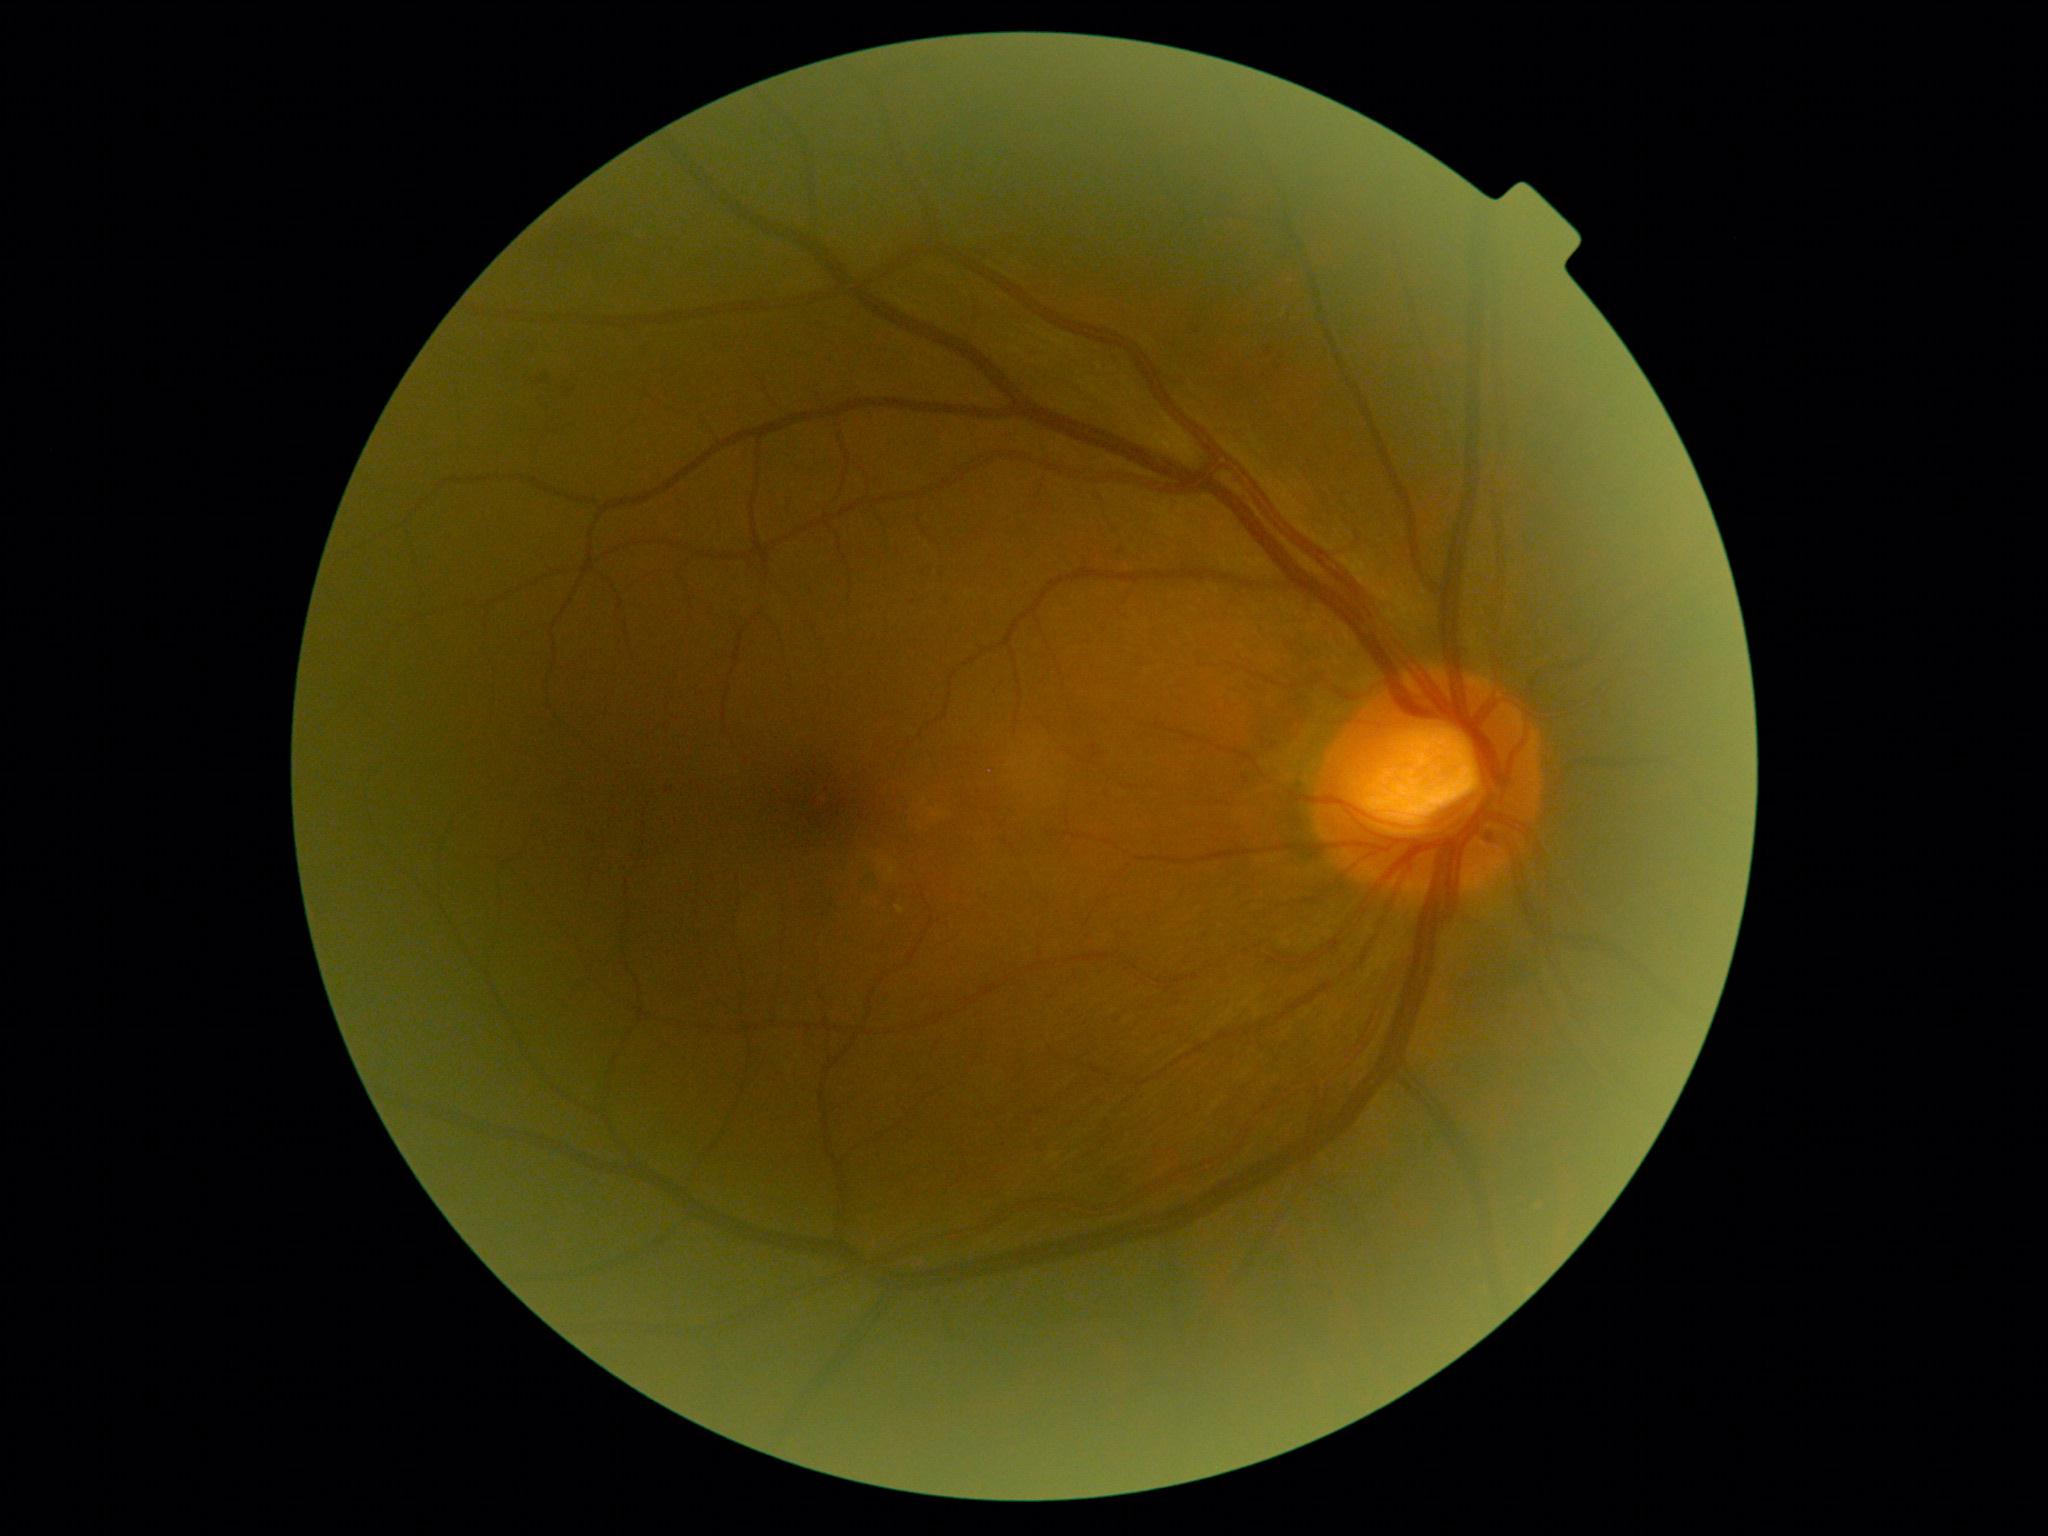

{
  "dr_grade": "2"
}